Kowa VX-10α.
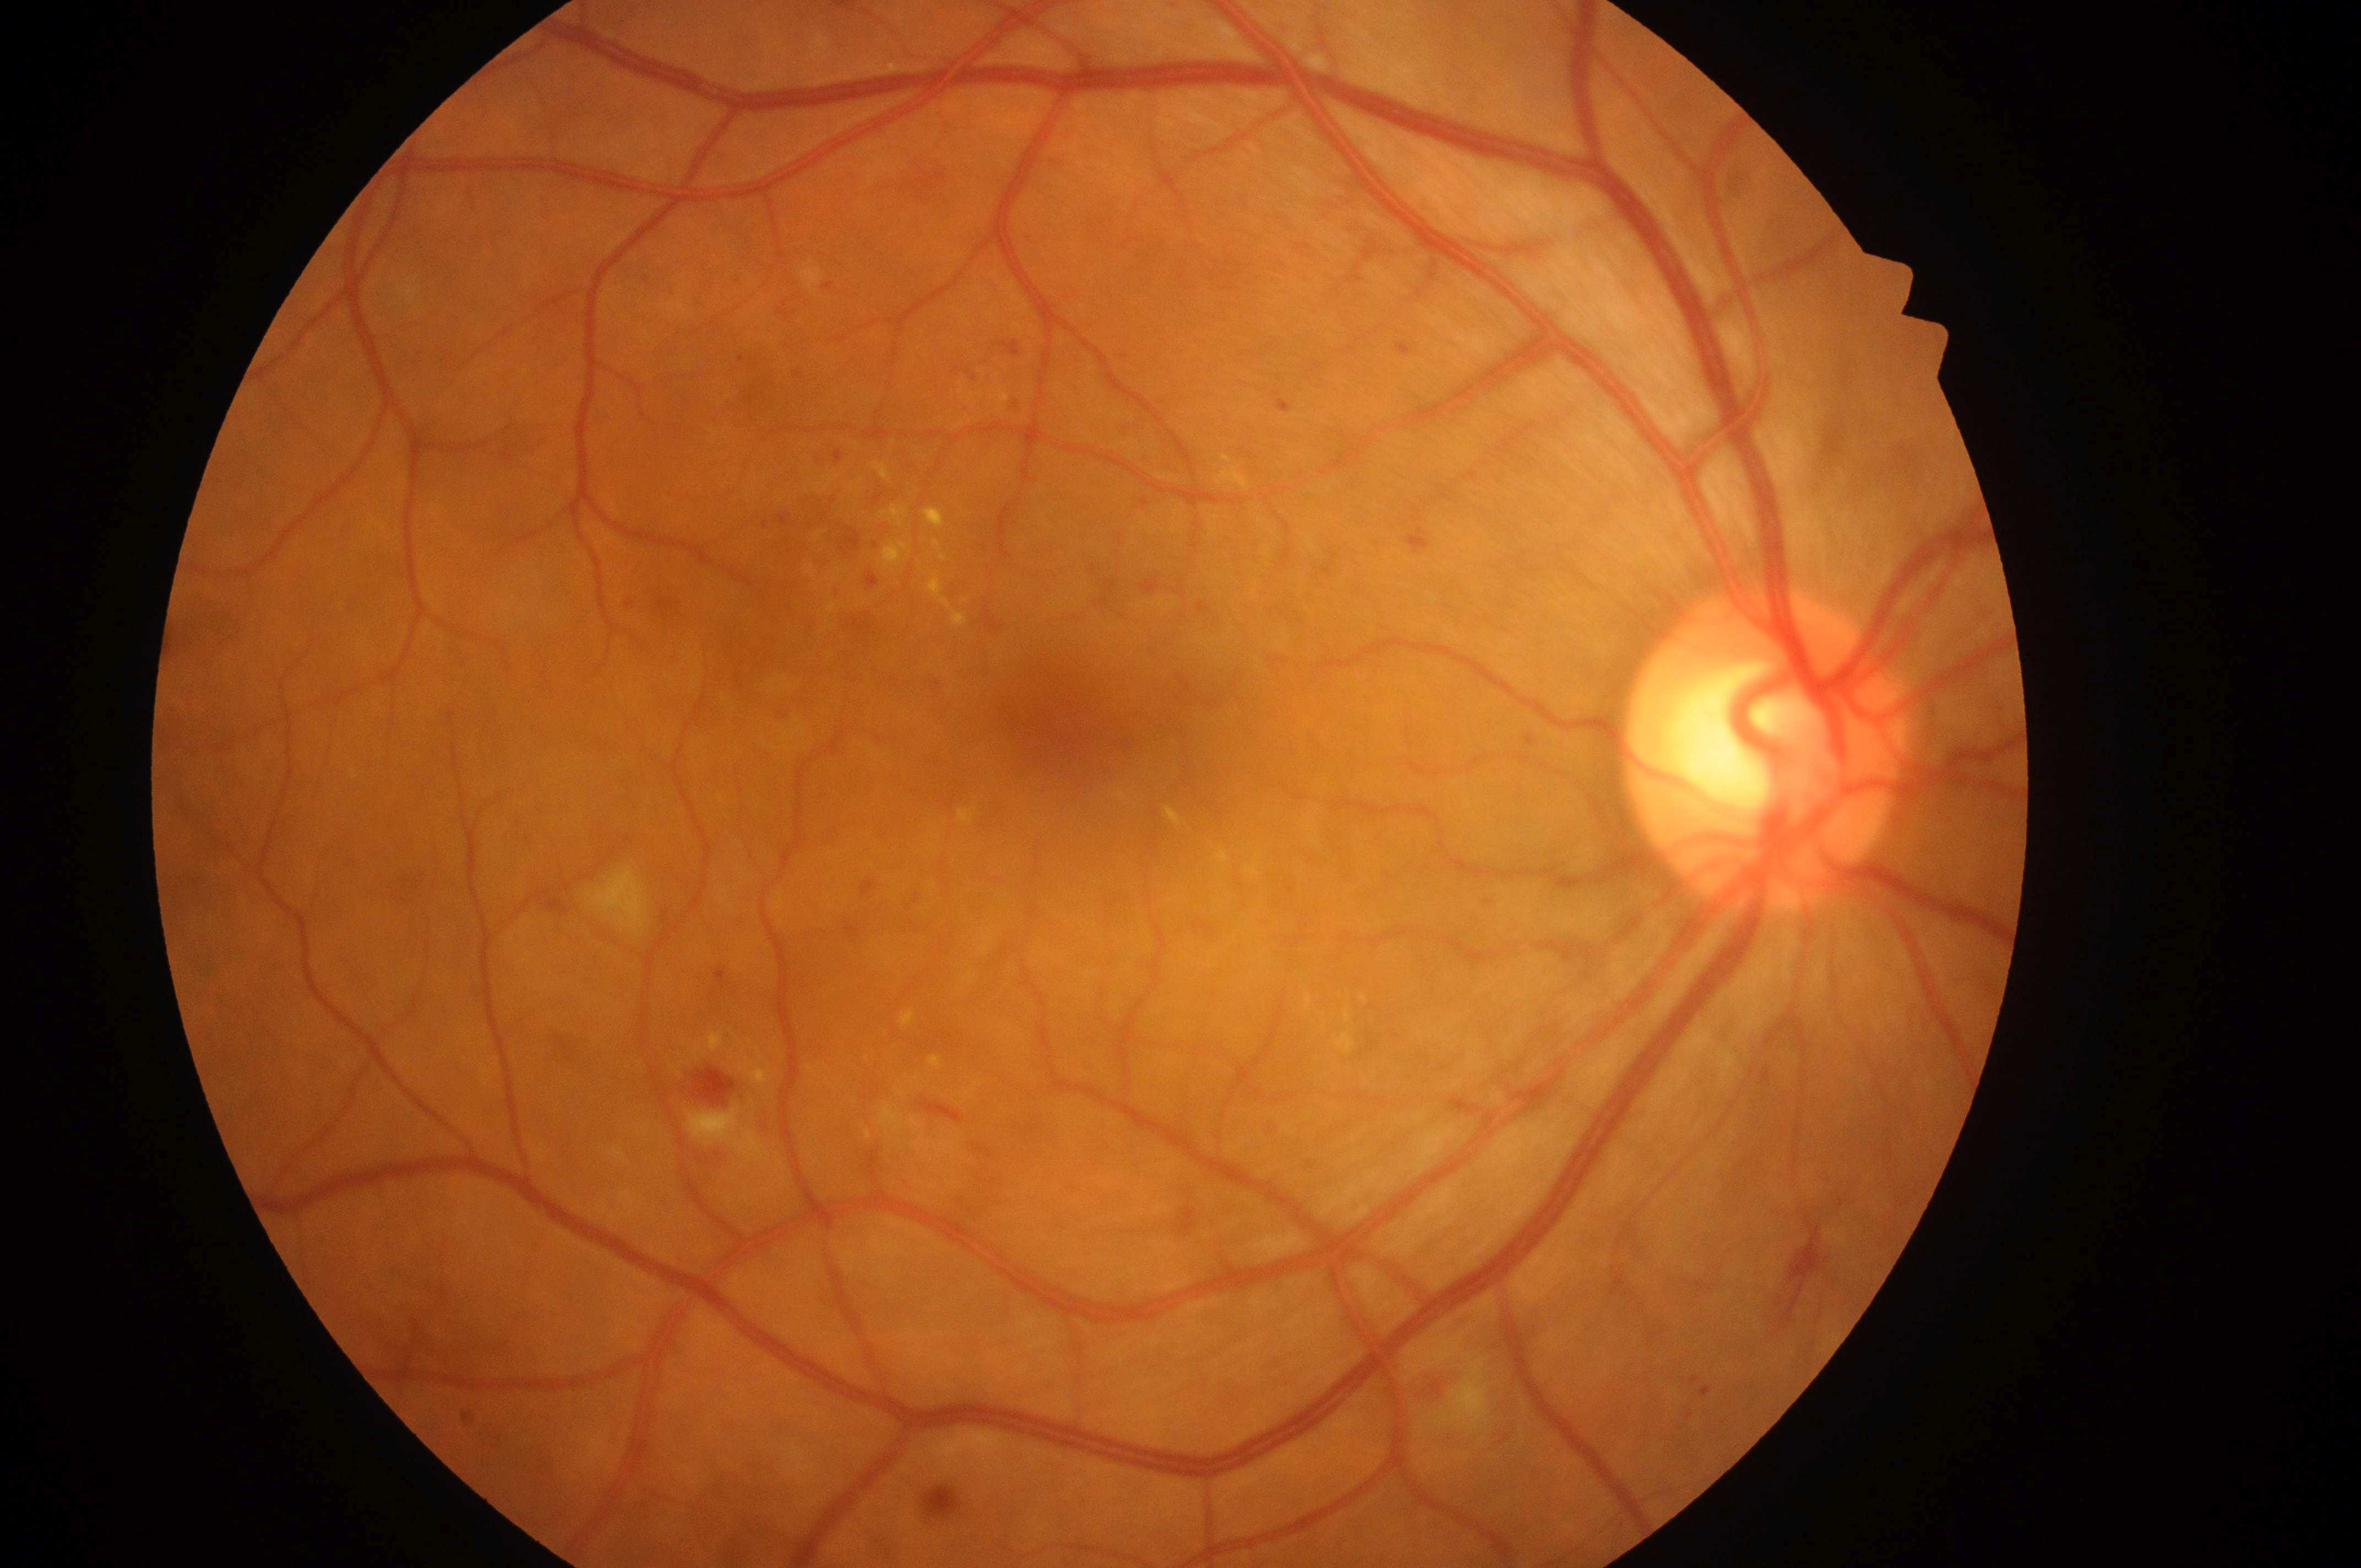 Eye: right.
DME grade is high risk (2).
Macula center located at (x: 1070, y: 726).
DR is grade 2 (moderate NPDR).
Optic disc located at (x: 1768, y: 760).